2212 by 1659 pixels, 45° FOV.
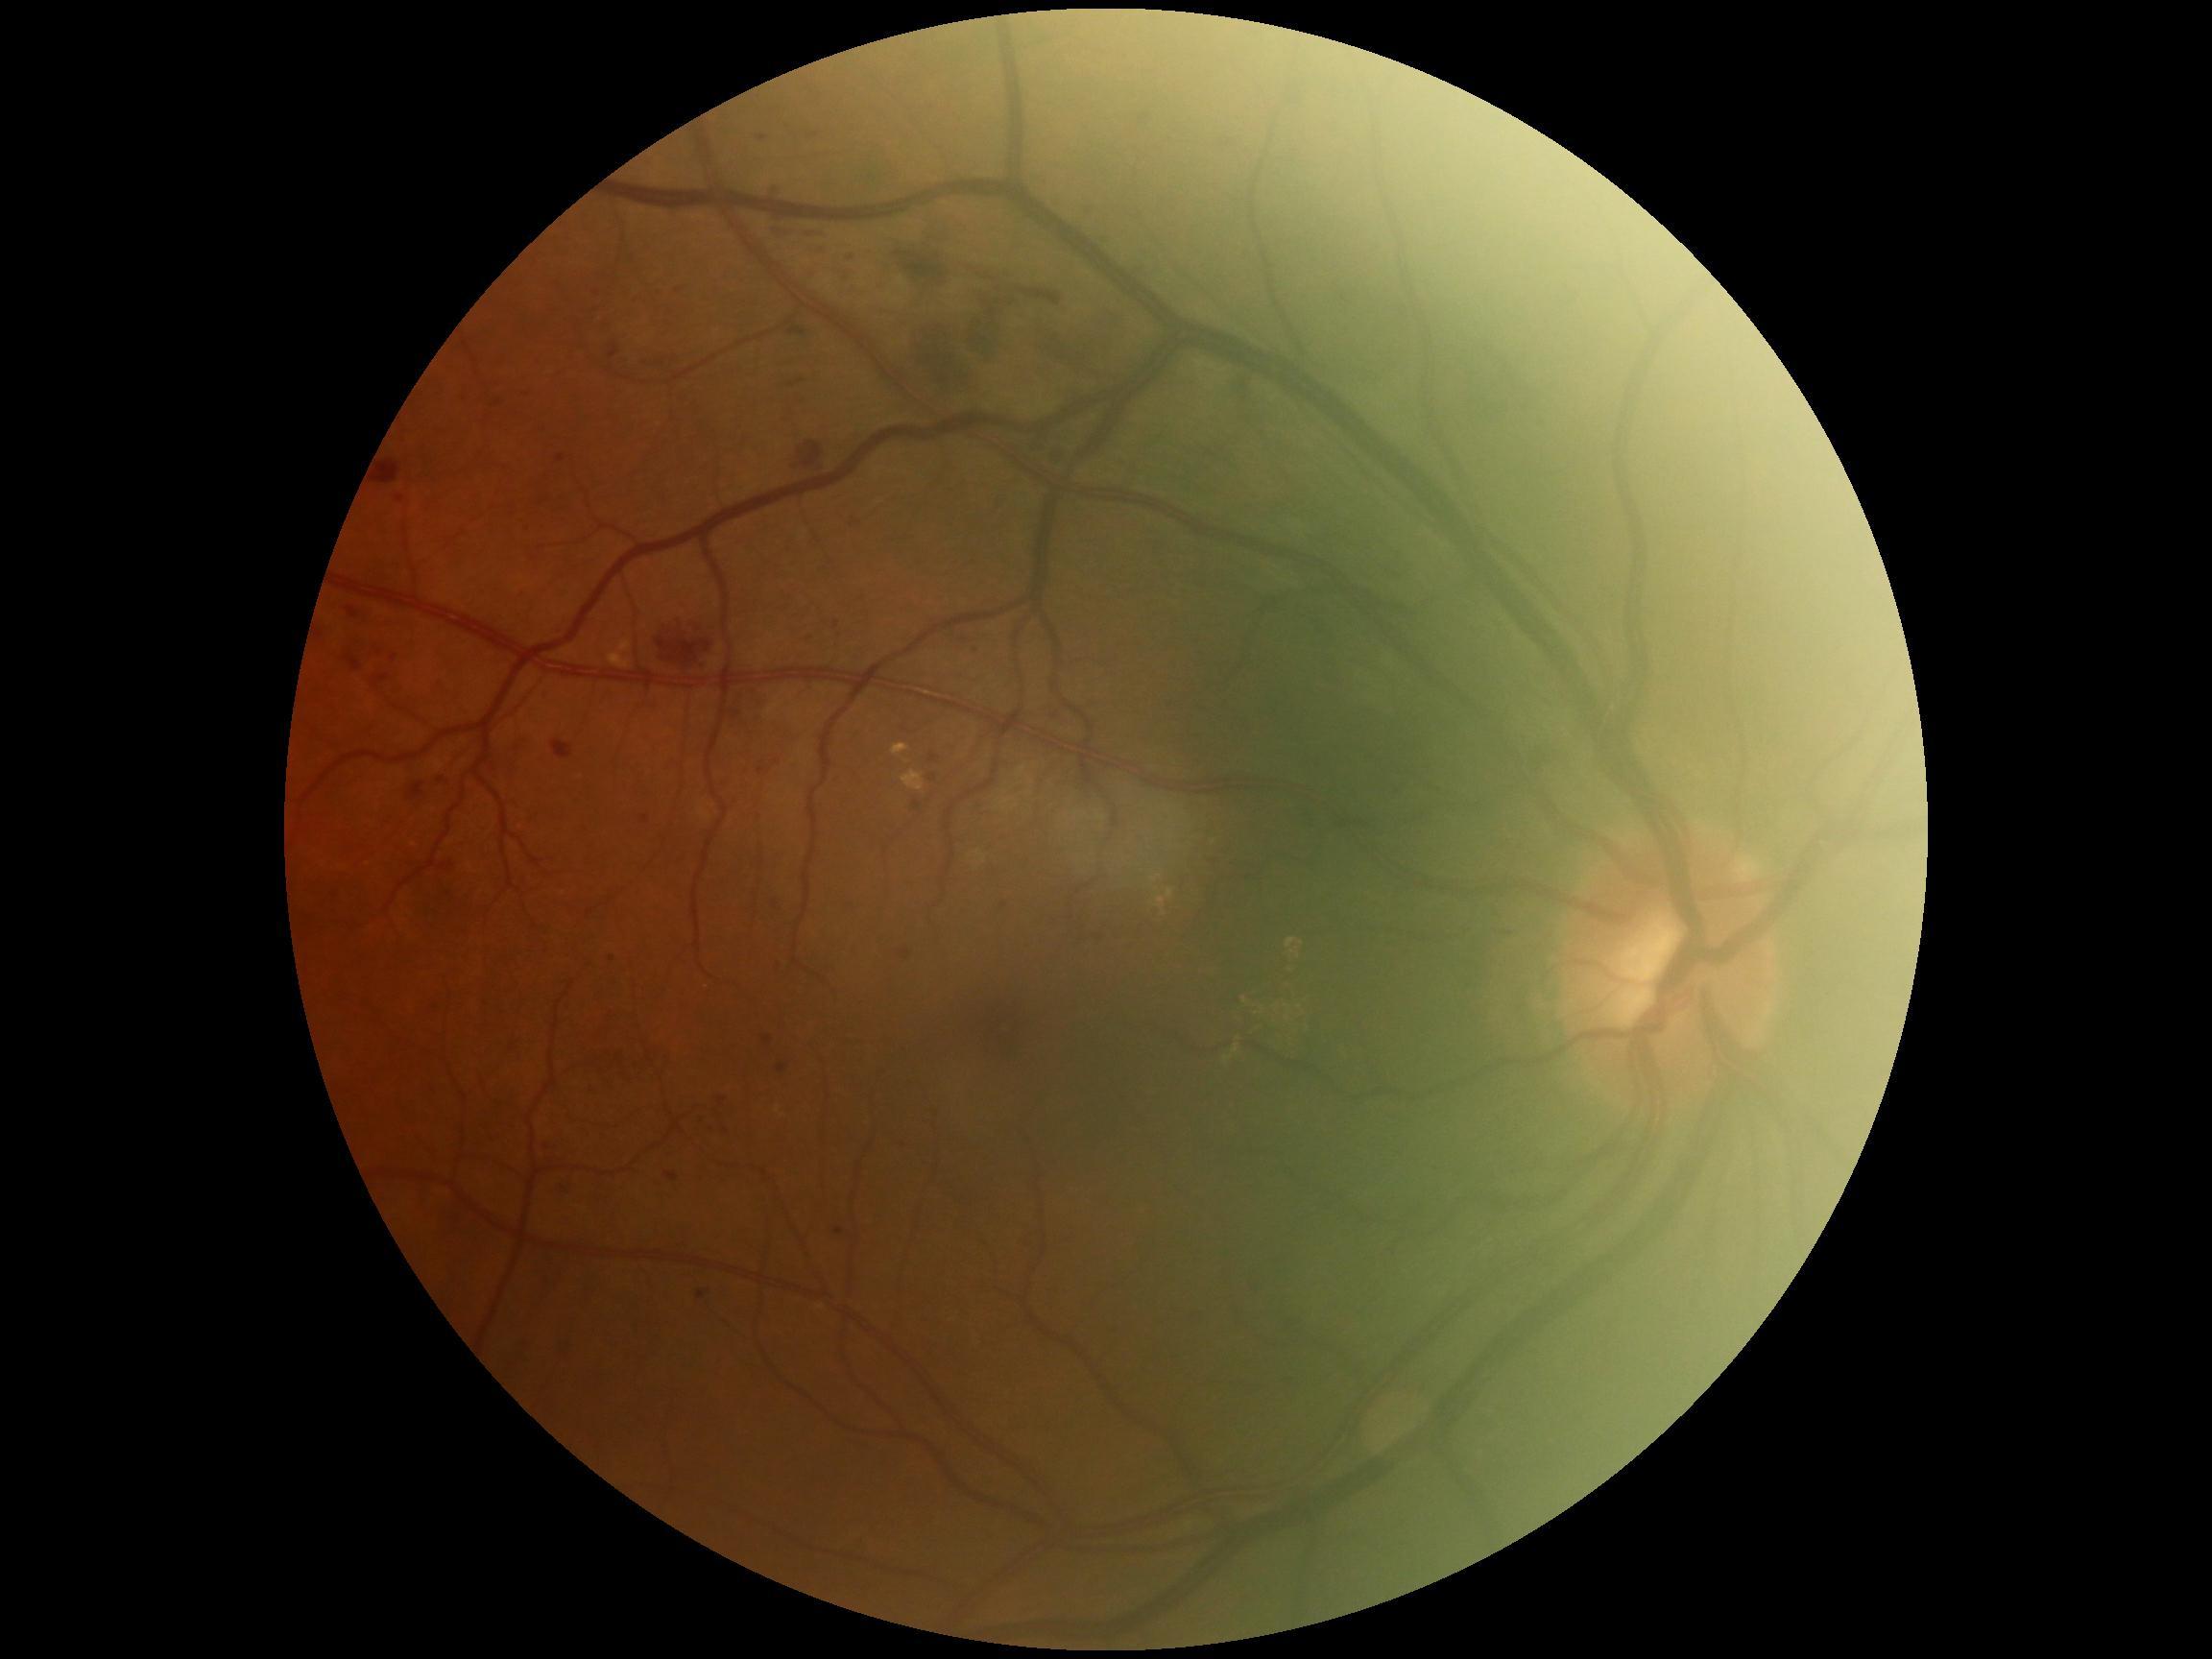
diabetic retinopathy (DR)@2/4 — more than just microaneurysms but less than severe NPDR.